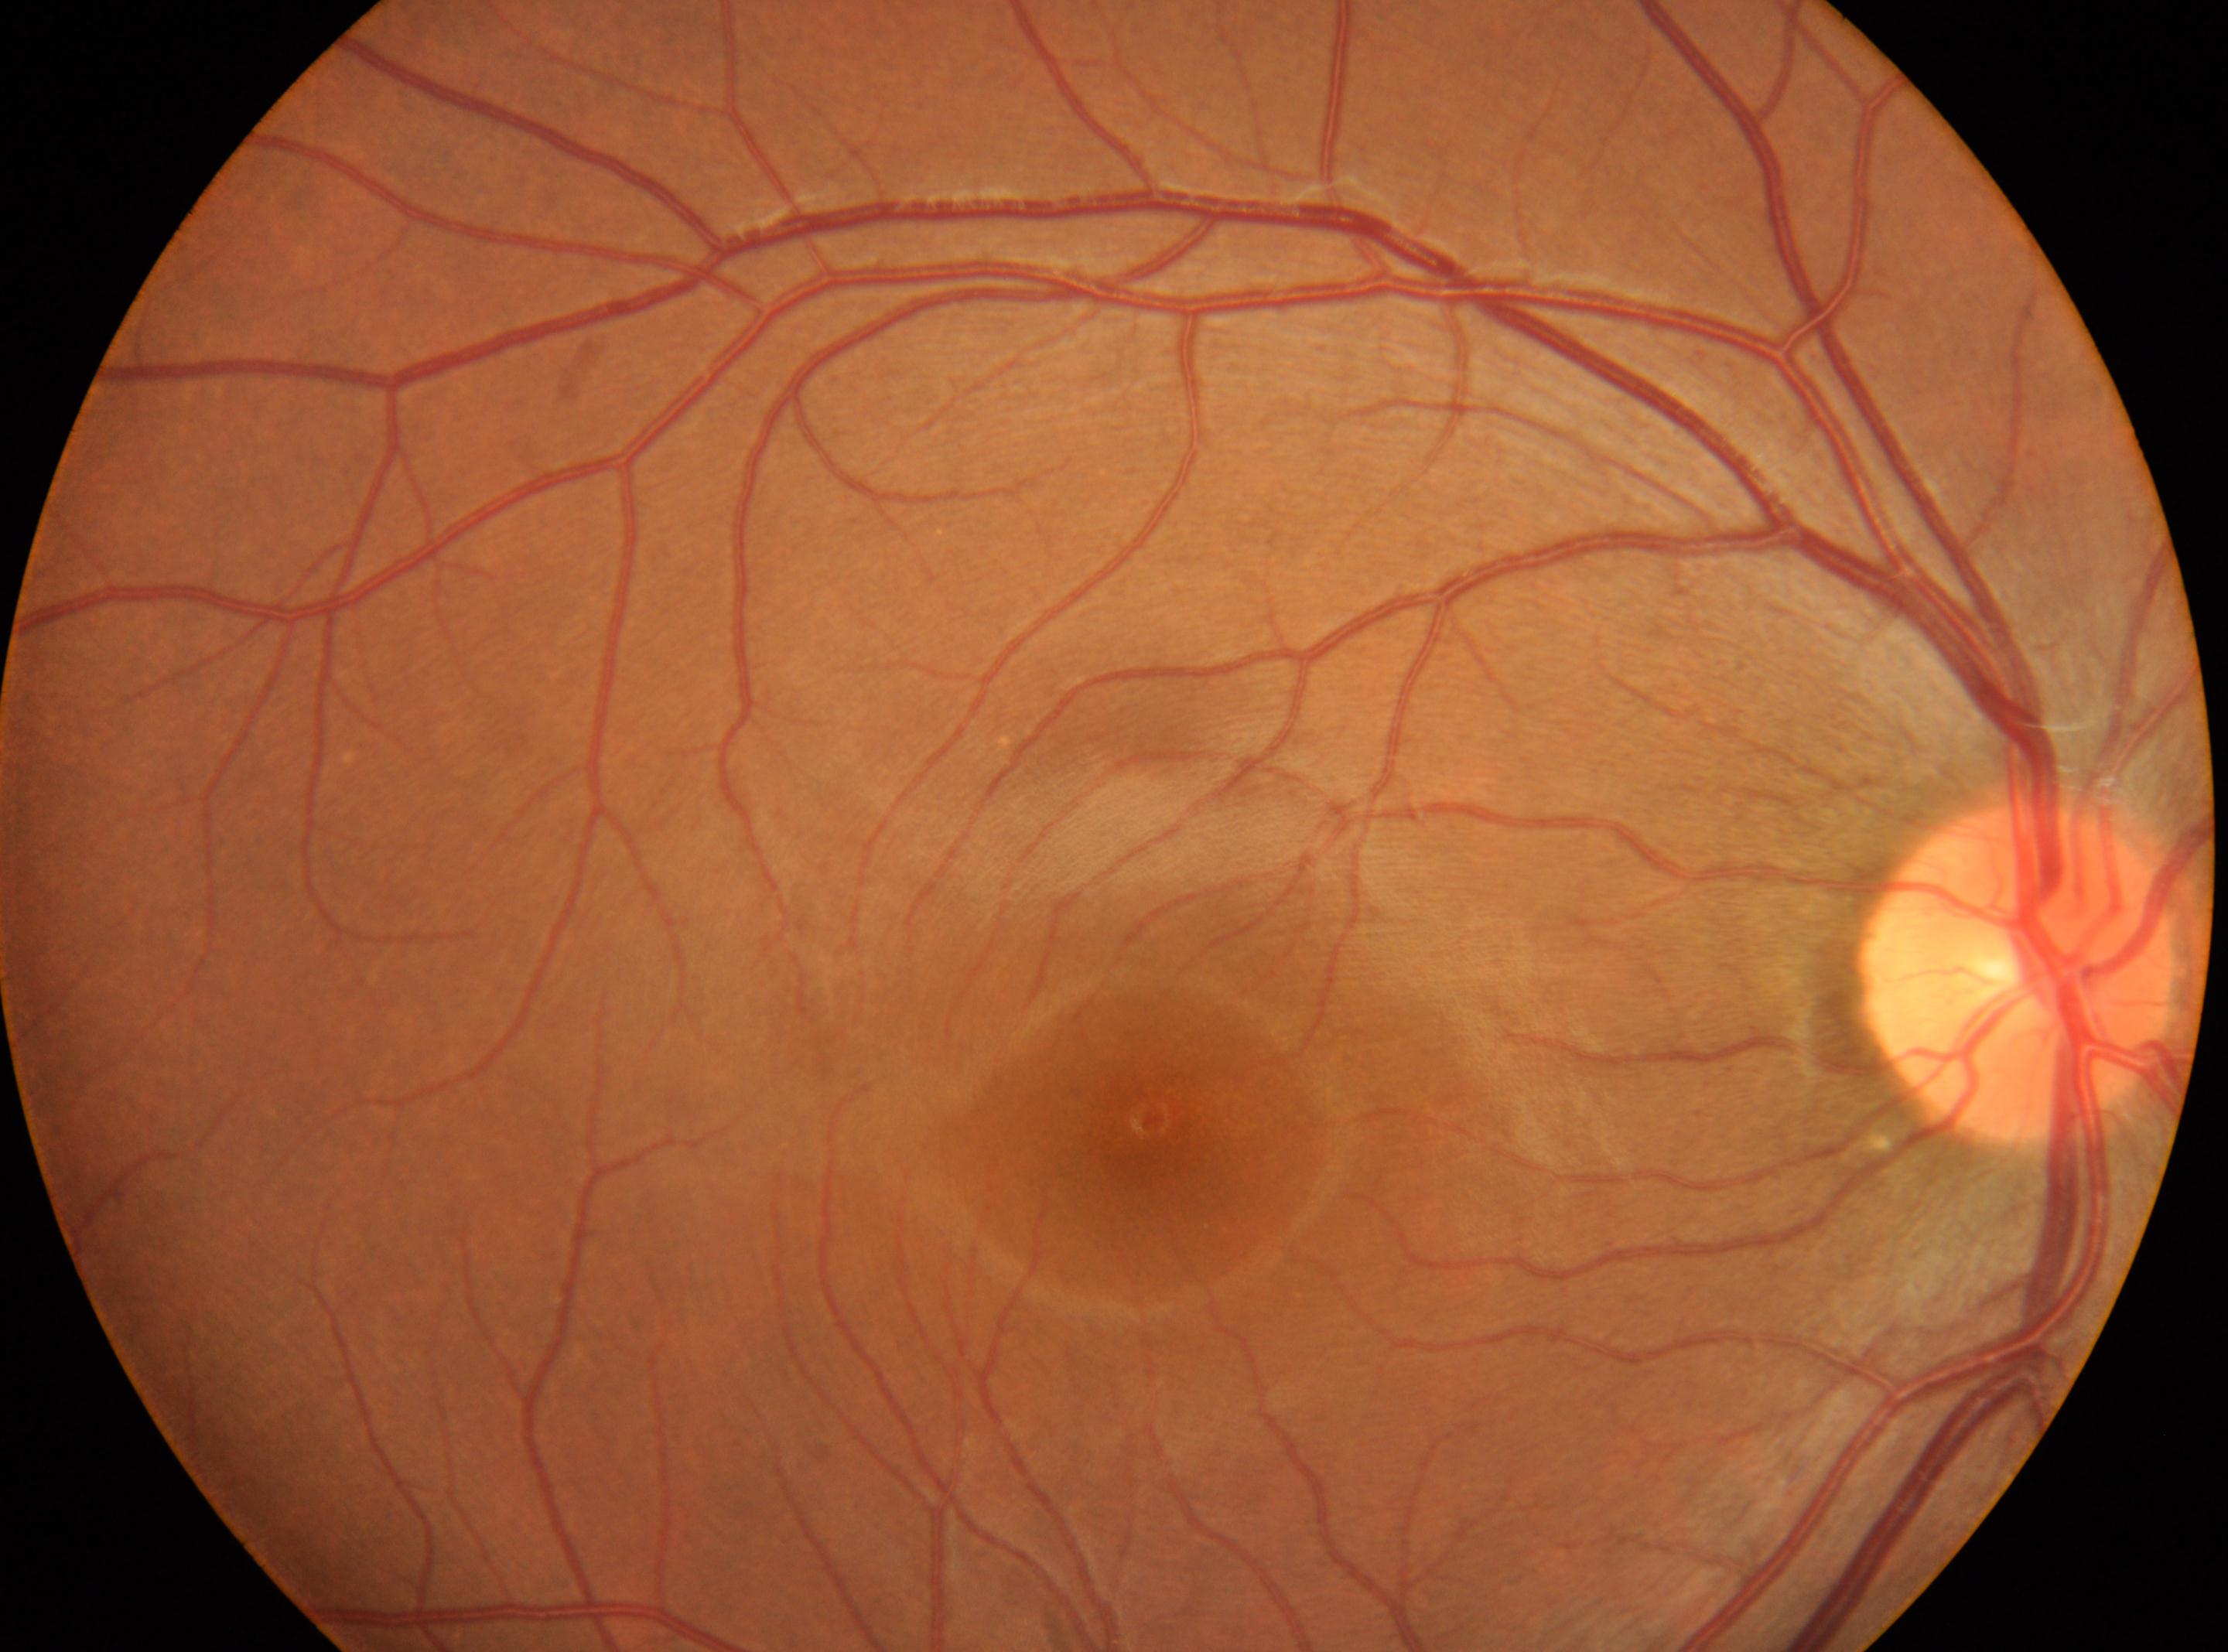
fovea center: (x=1151, y=1121), DR impression: No diabetic retinopathy identified, laterality: right, optic disc center: (x=2015, y=973), diabetic retinopathy (DR): grade 0.